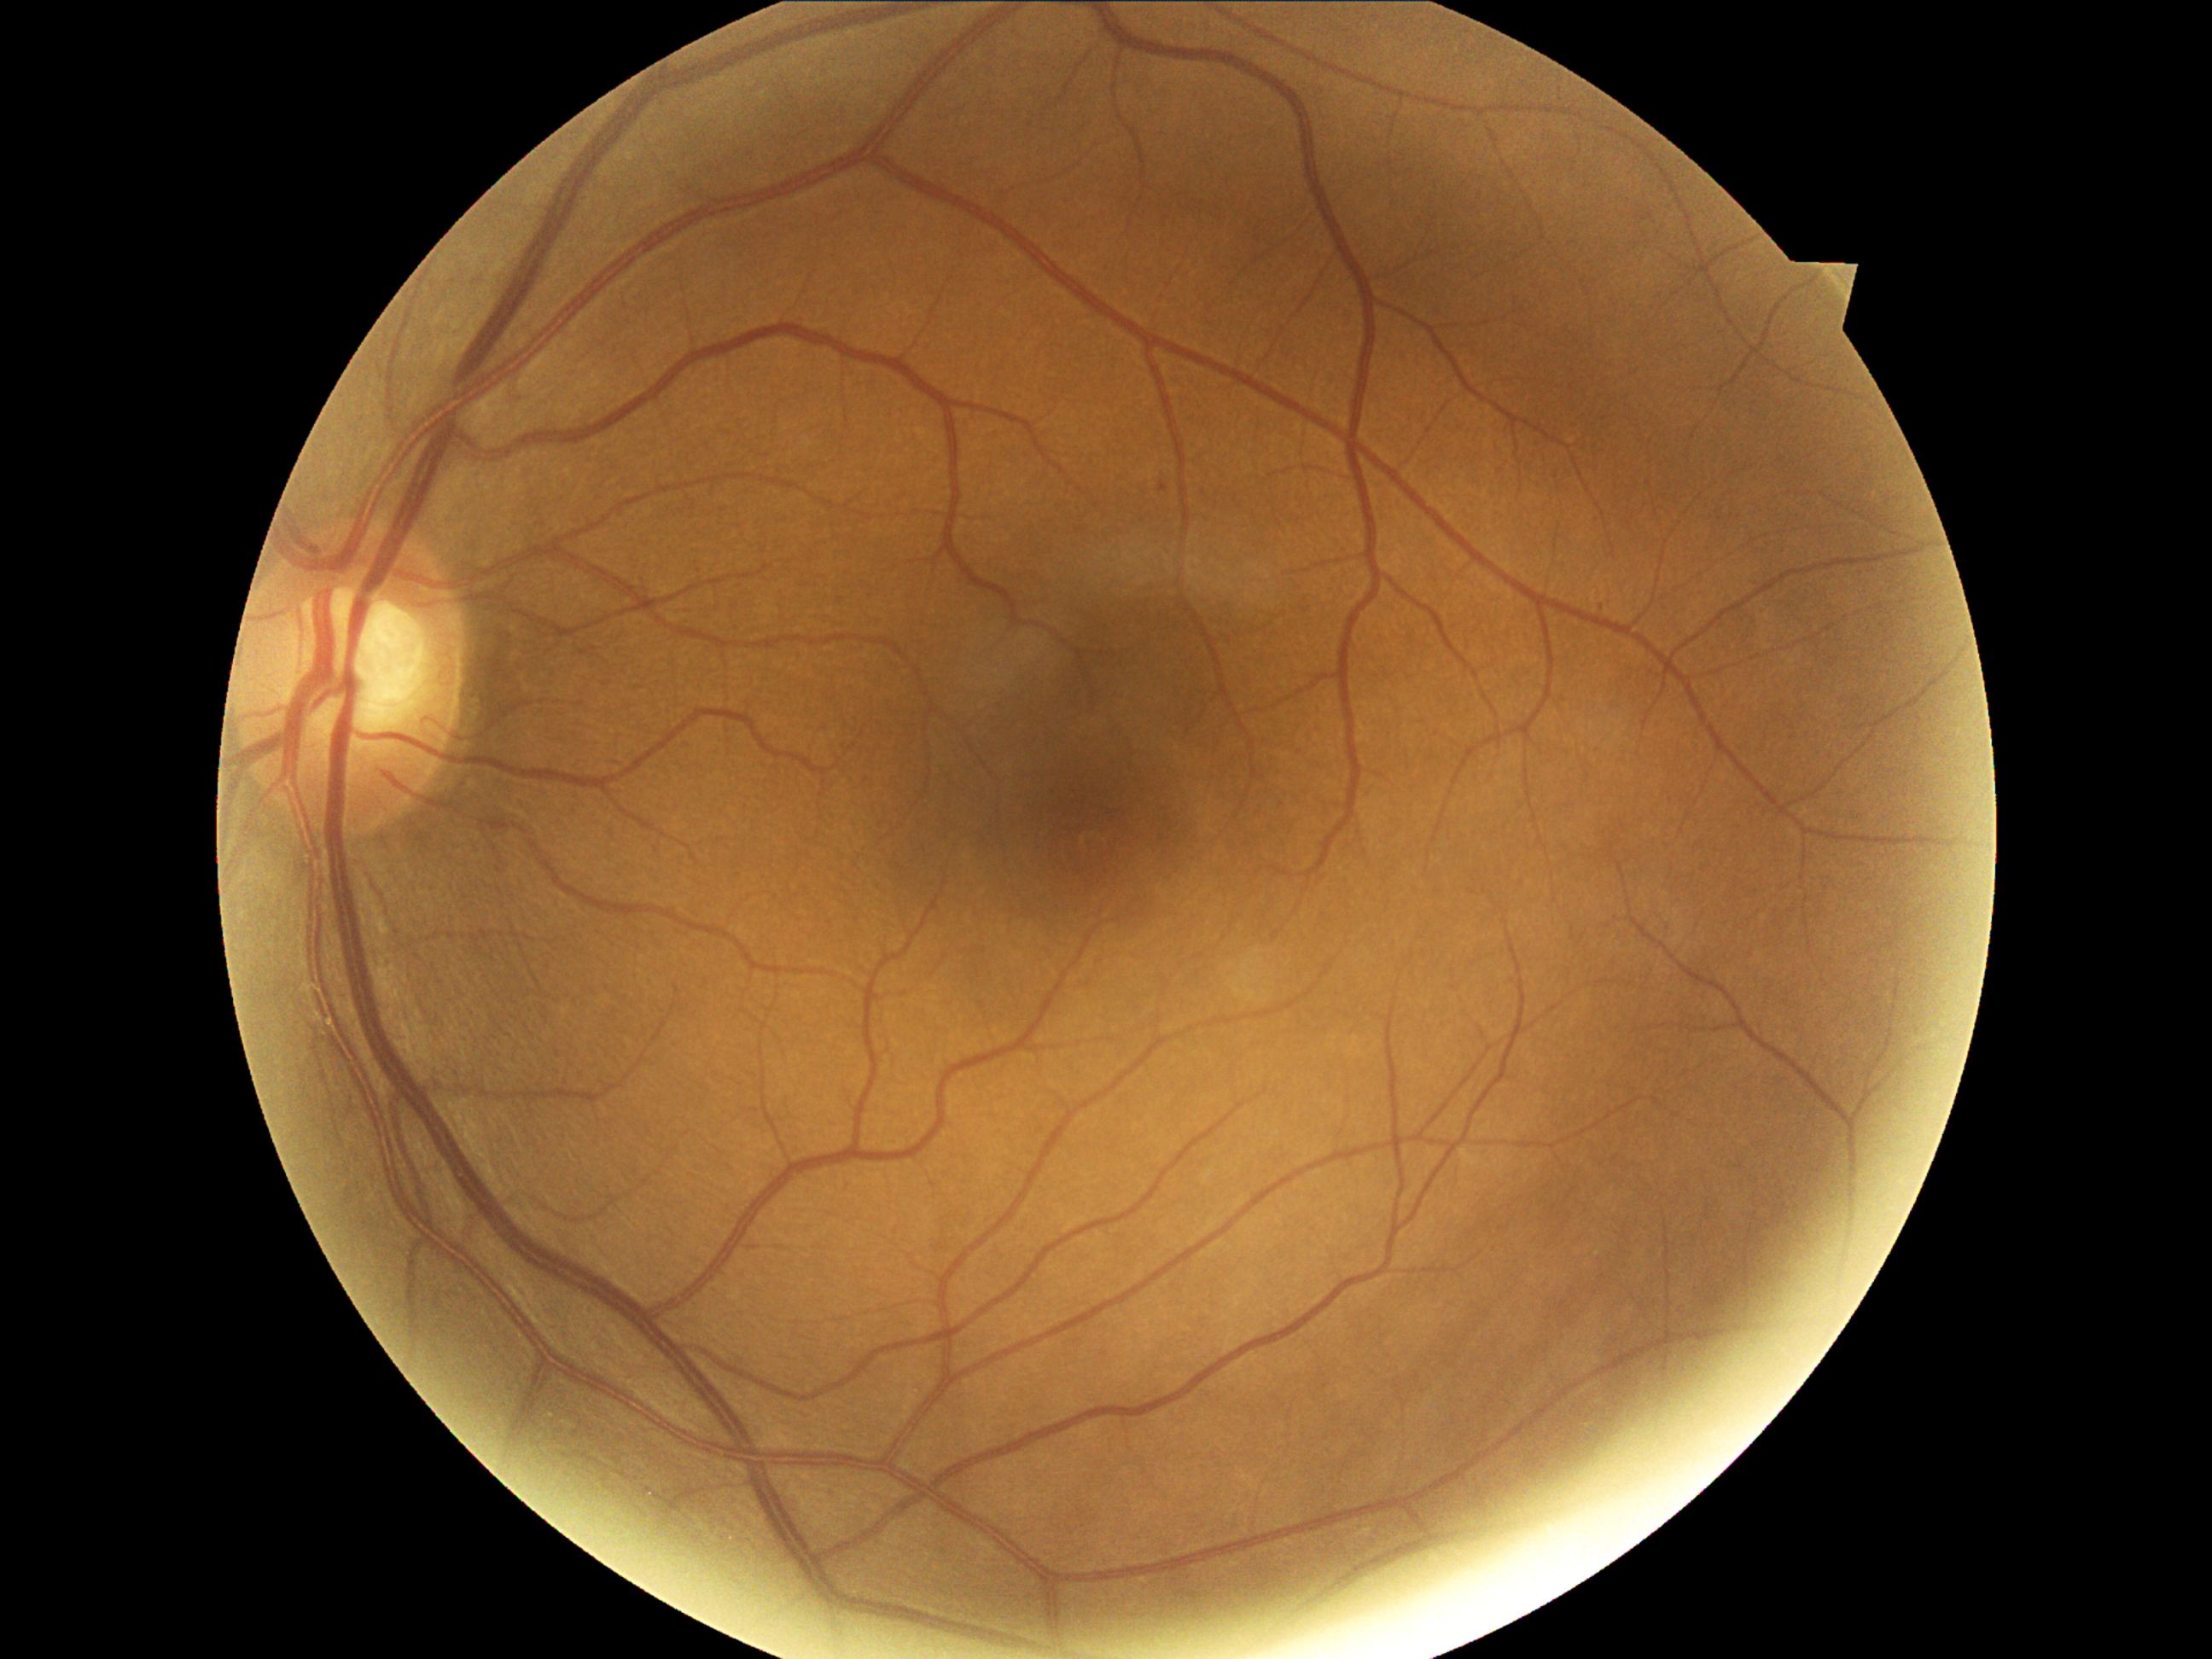 {"dr_grade": "mild NPDR (1)"}